1240x1240px · Phoenix ICON wide-field infant fundus image: 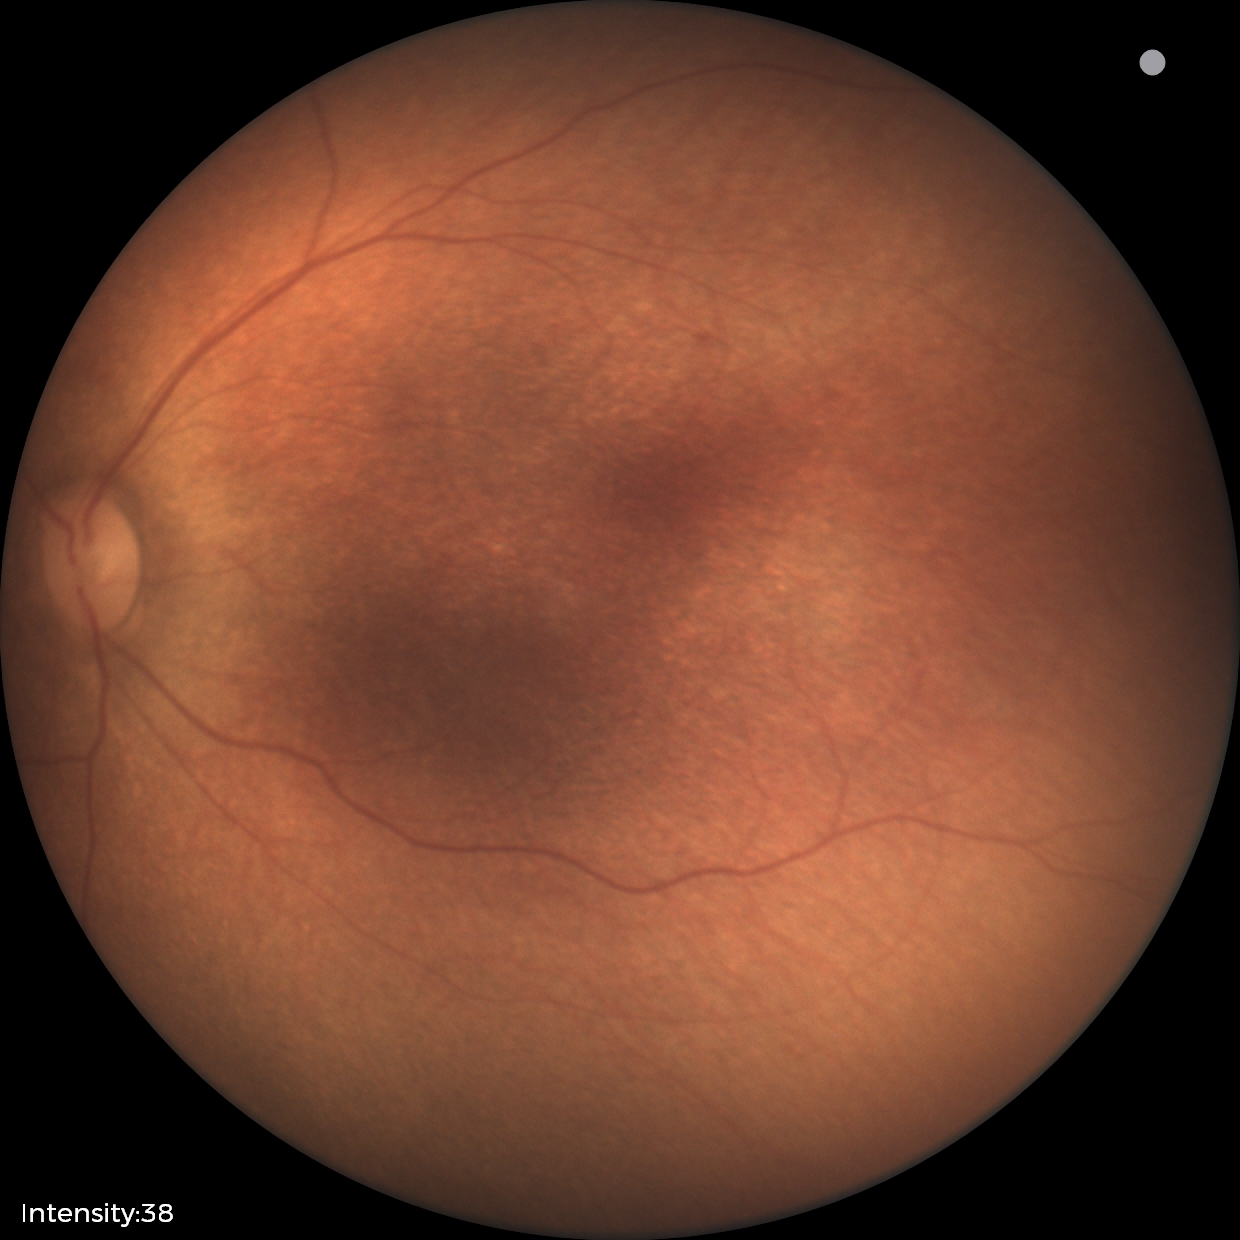 Finding = no abnormalities.